Wide-field contact fundus photograph of an infant. 130° field of view (Clarity RetCam 3) — 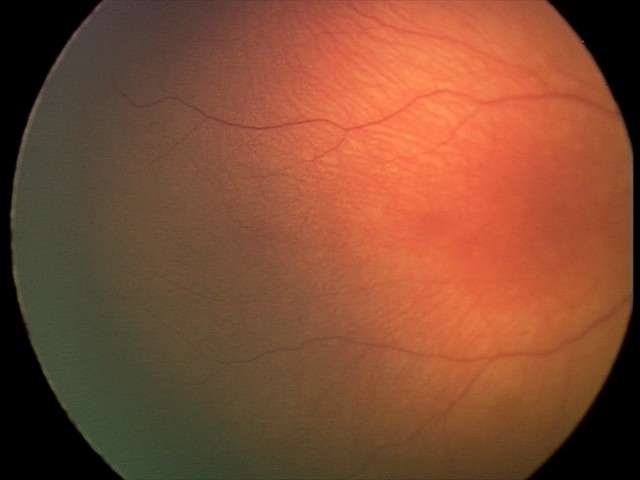

Screening: normal retinal appearance.